Captured on a Nidek AFC-330 fundus camera, color fundus photograph.
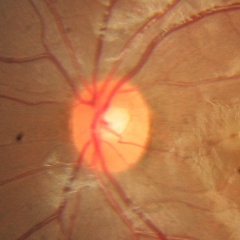

Demonstrates no glaucomatous optic neuropathy.